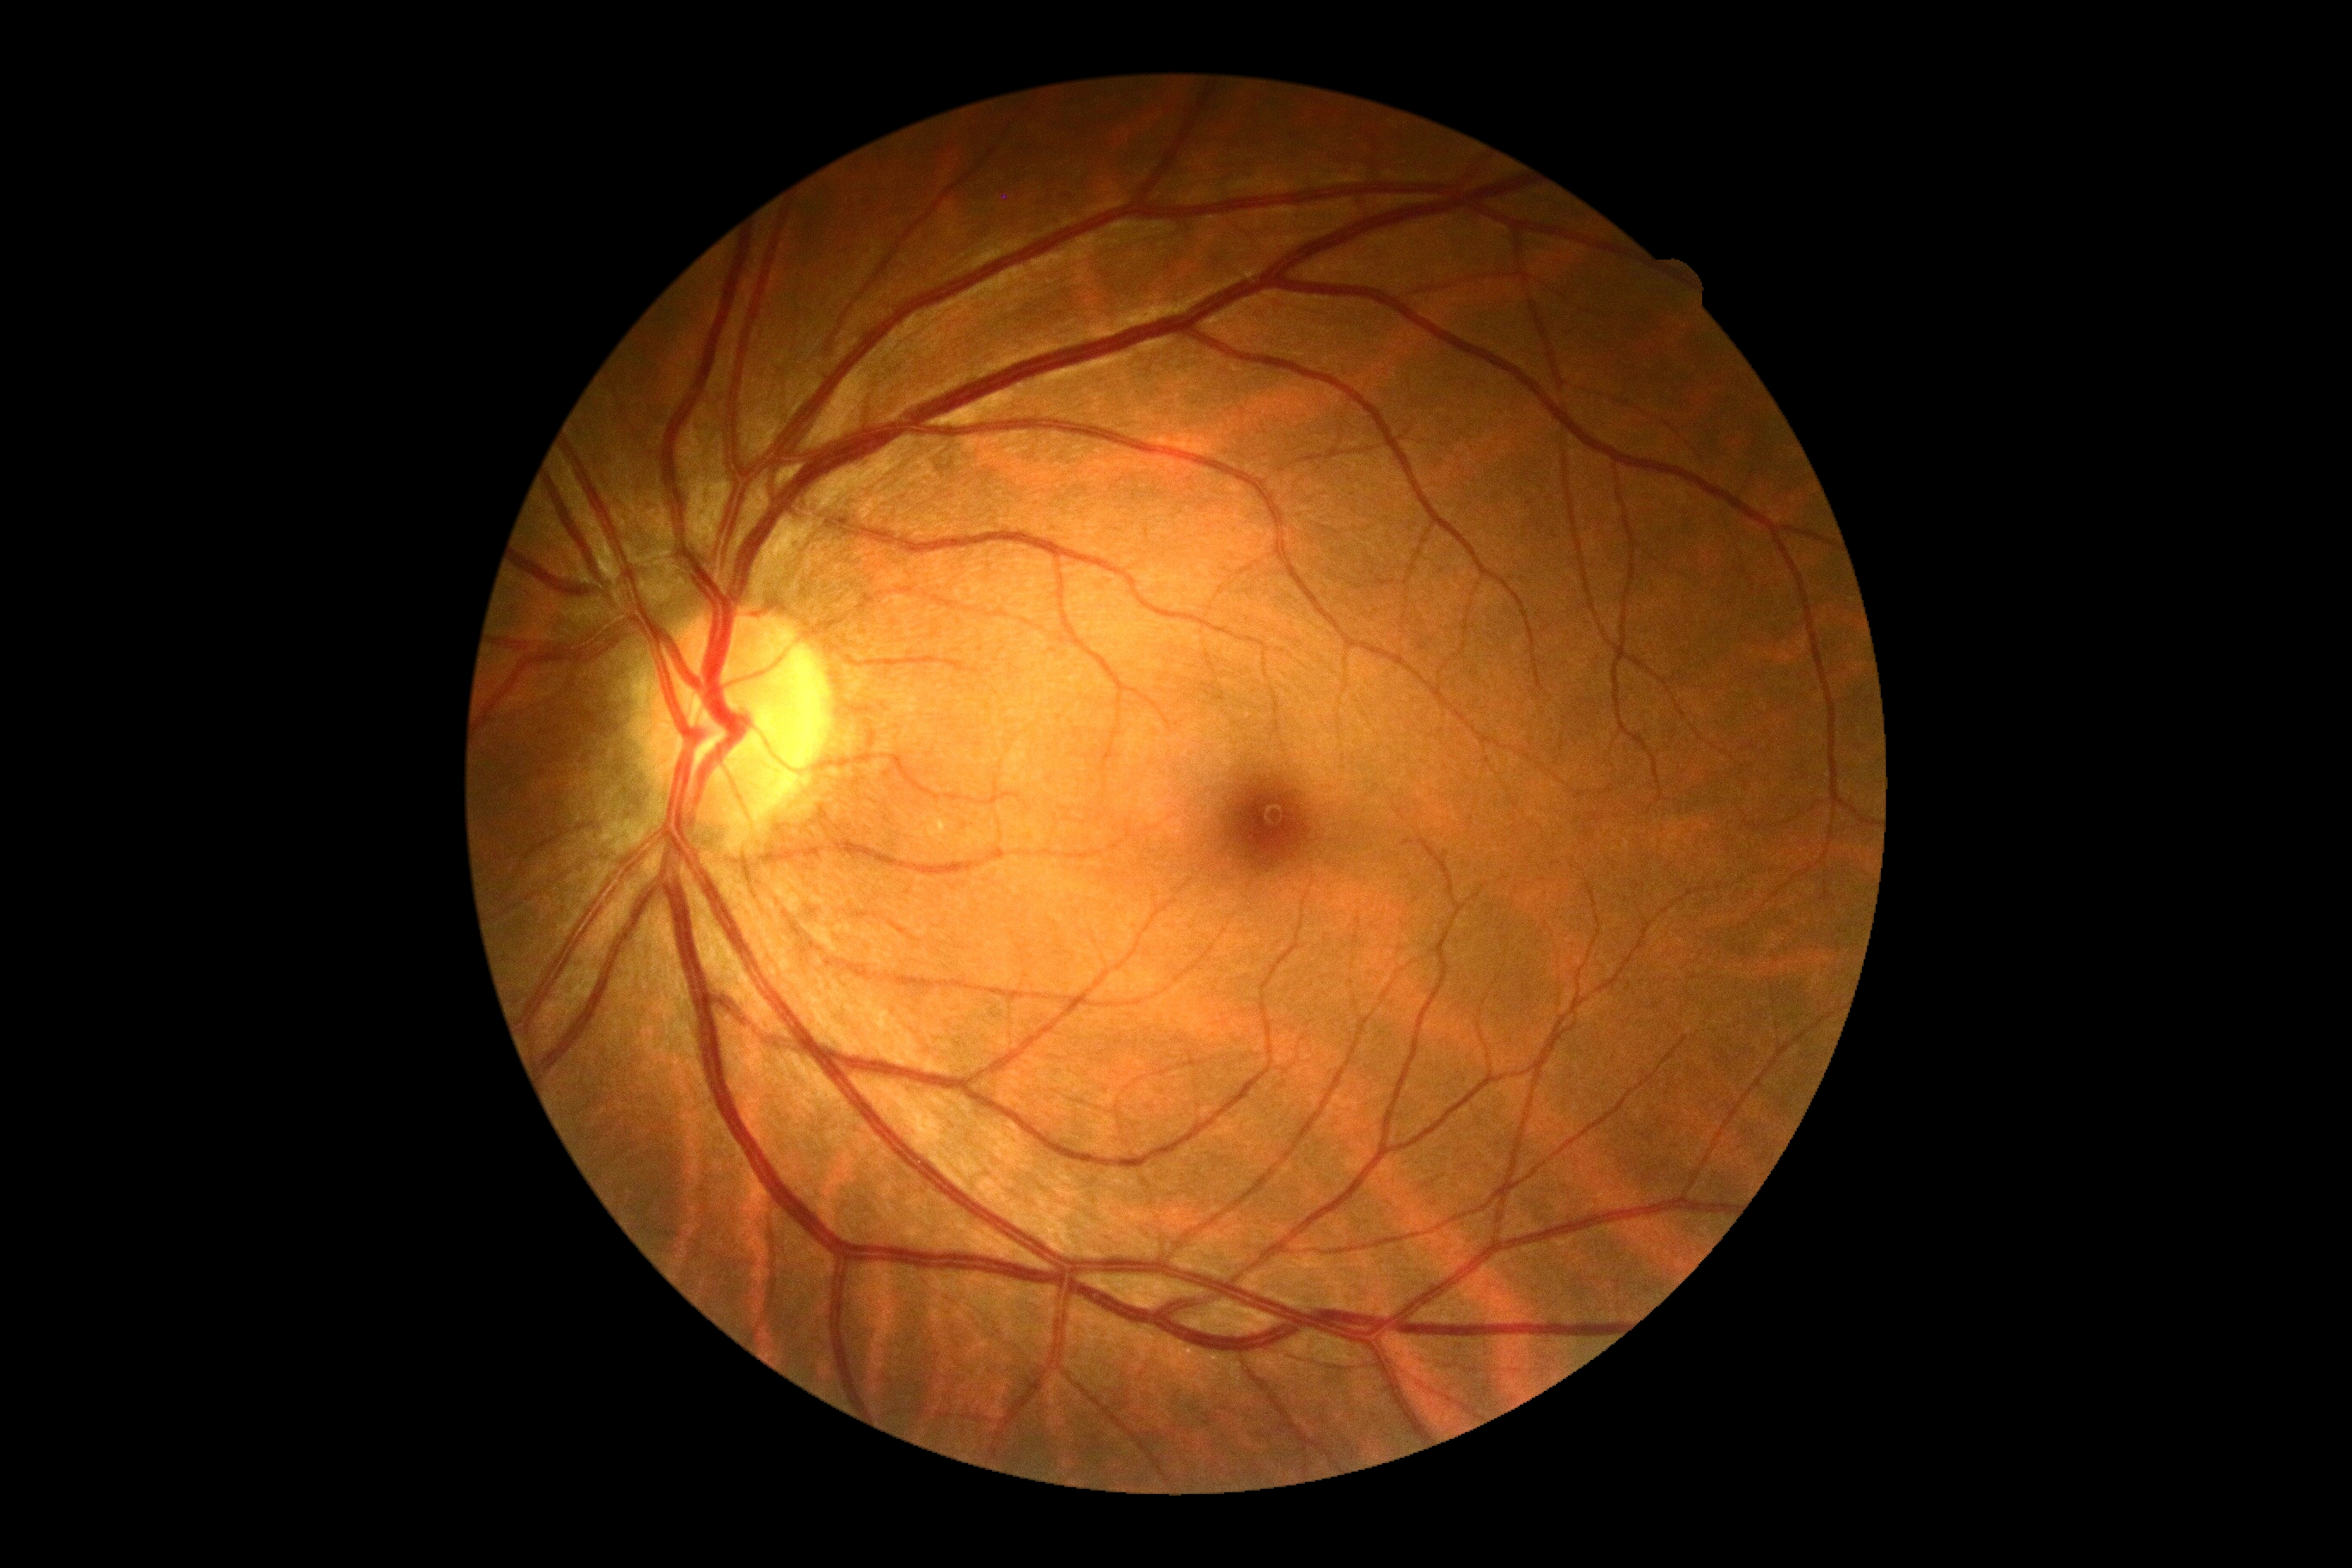
diabetic retinopathy@grade 0.